Graded on the modified Davis scale:
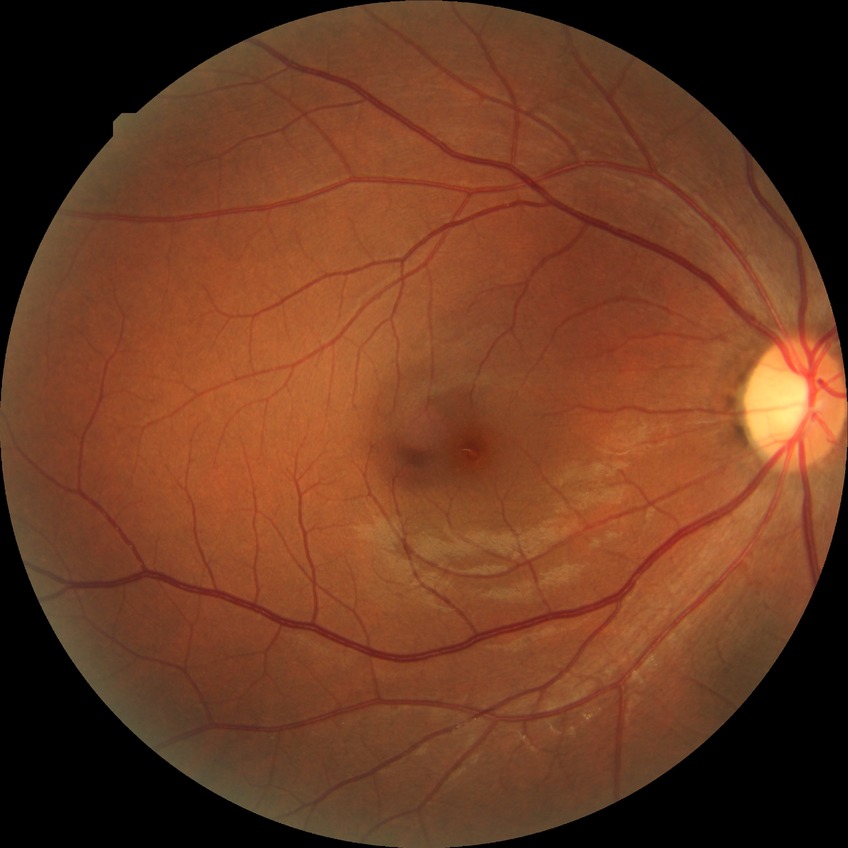

diabetic retinopathy (DR) = NDR (no diabetic retinopathy)